45-degree field of view, image size 2352x1568 — 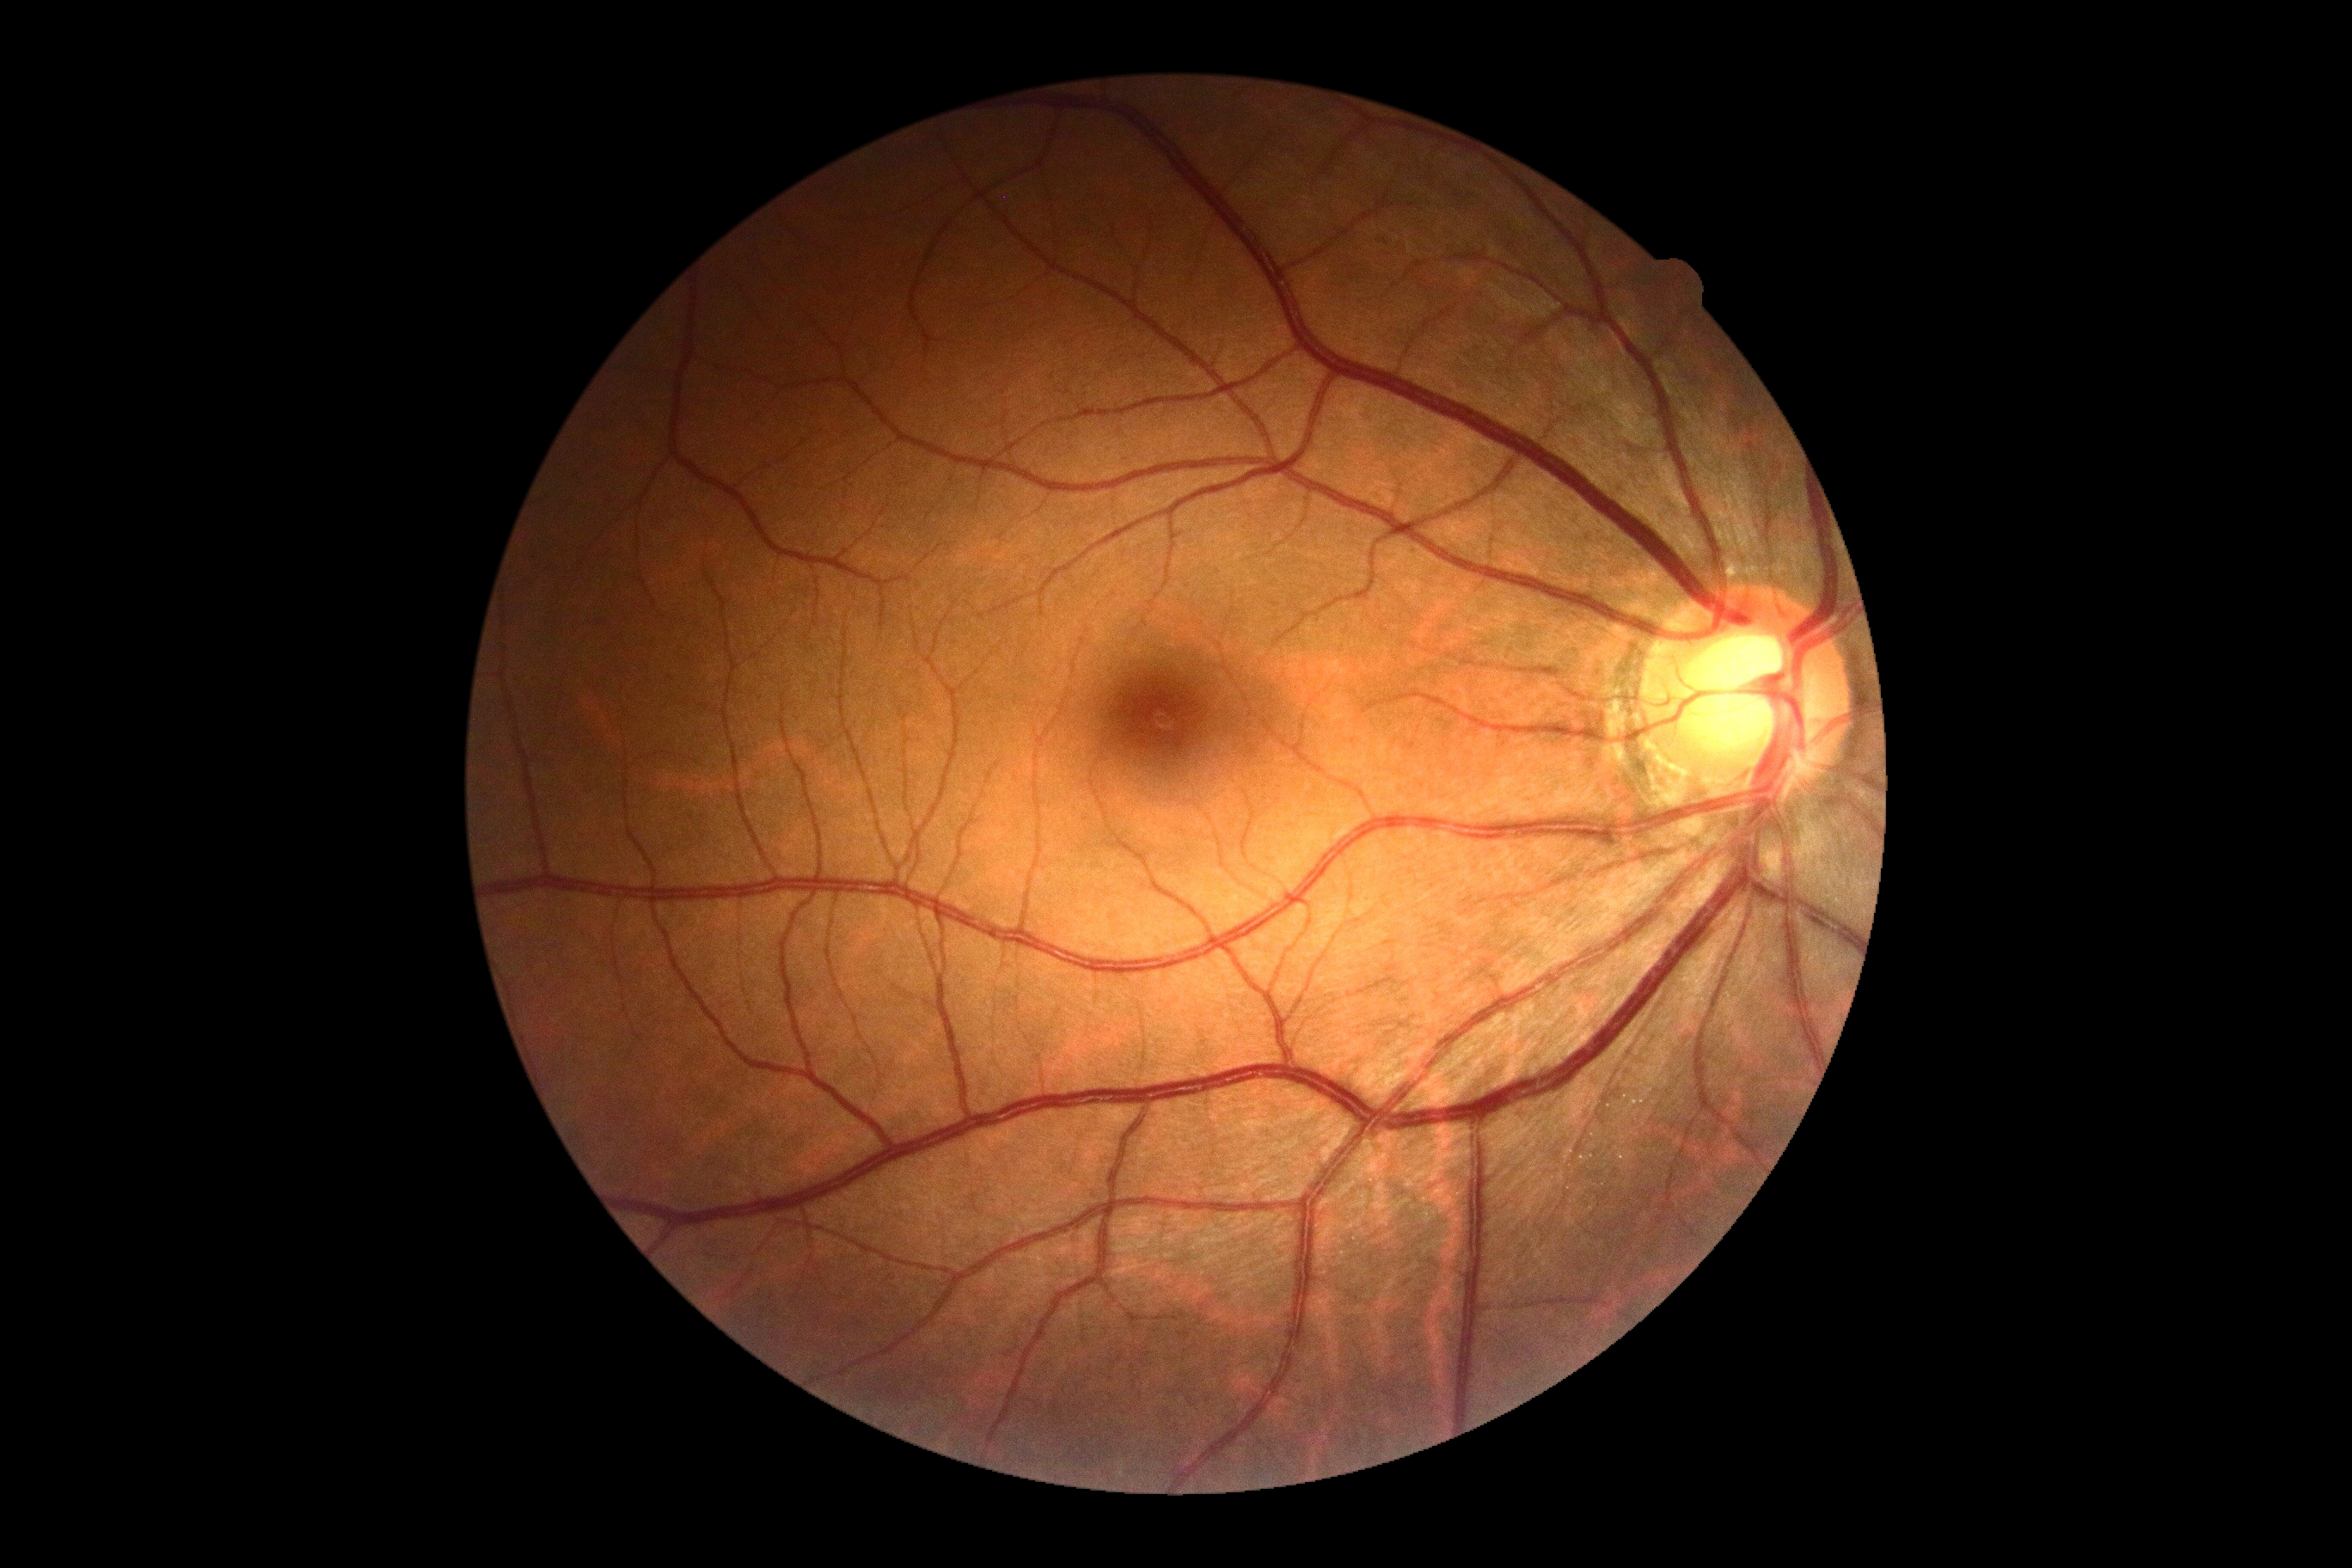

{"dr_grade": "no apparent diabetic retinopathy (grade 0)", "dr_impression": "negative for DR"}